Modified Davis classification.
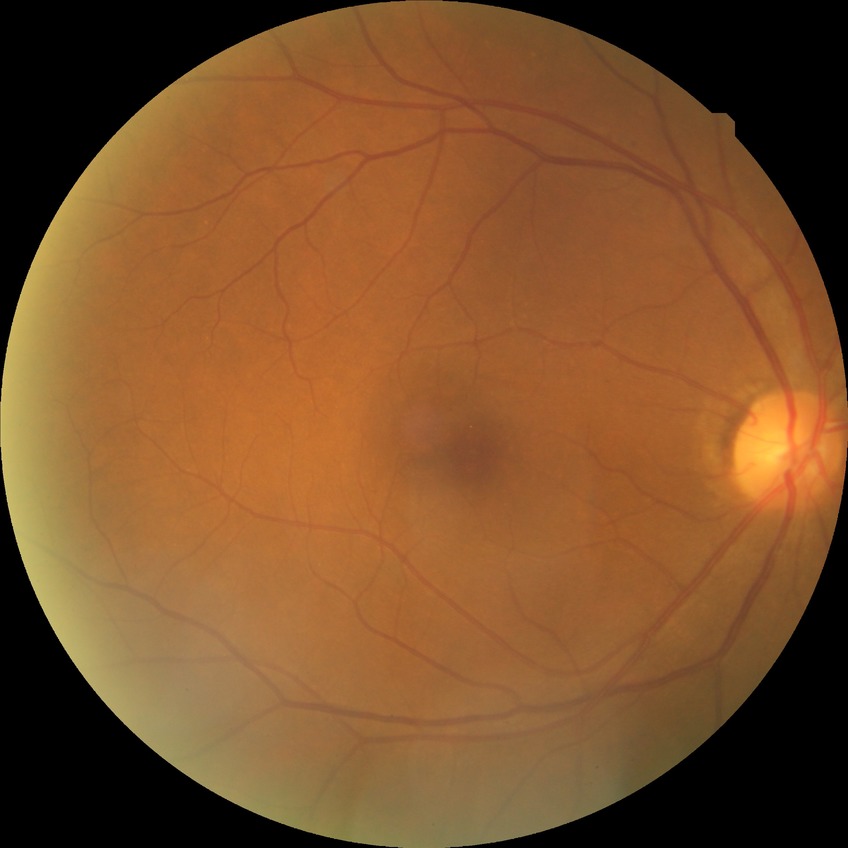

diabetic retinopathy (DR): no diabetic retinopathy (NDR).